45-degree field of view. DR severity per modified Davis staging. NIDEK AFC-230 fundus camera:
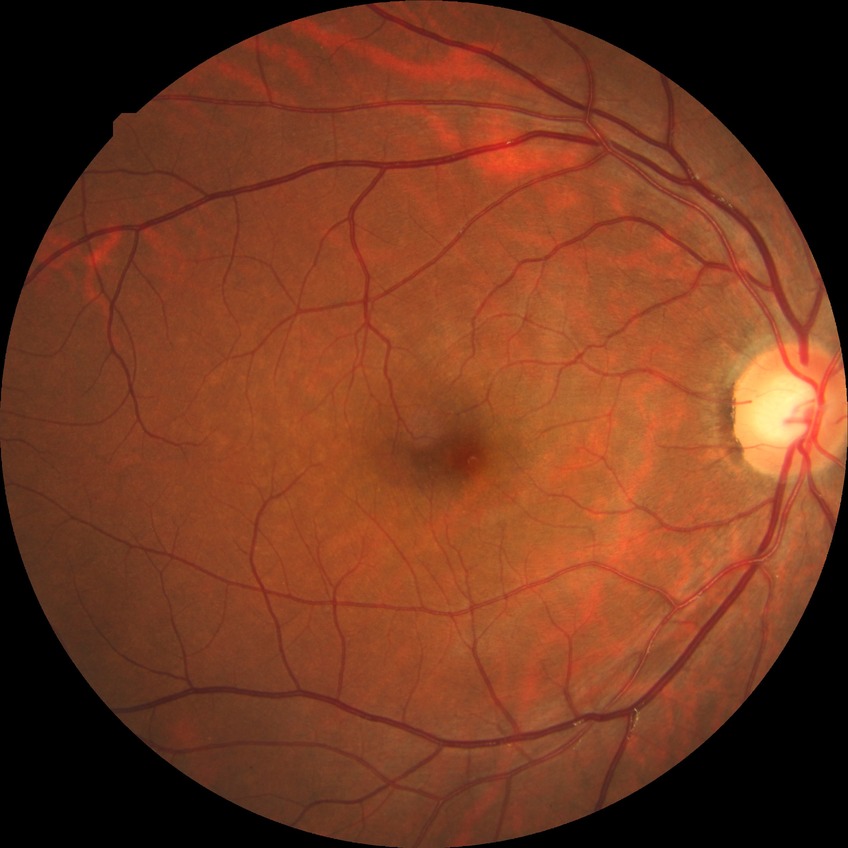
- diabetic retinopathy severity — no diabetic retinopathy